Camera: NIDEK AFC-230 · fundus photo: 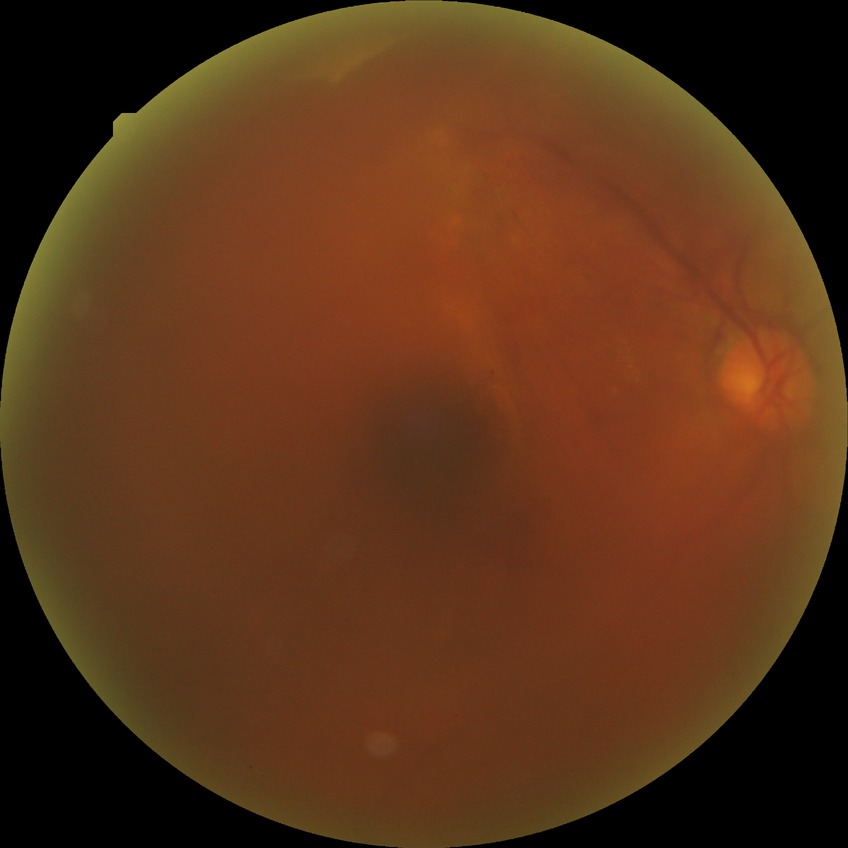

diabetic retinopathy grade = proliferative diabetic retinopathy.